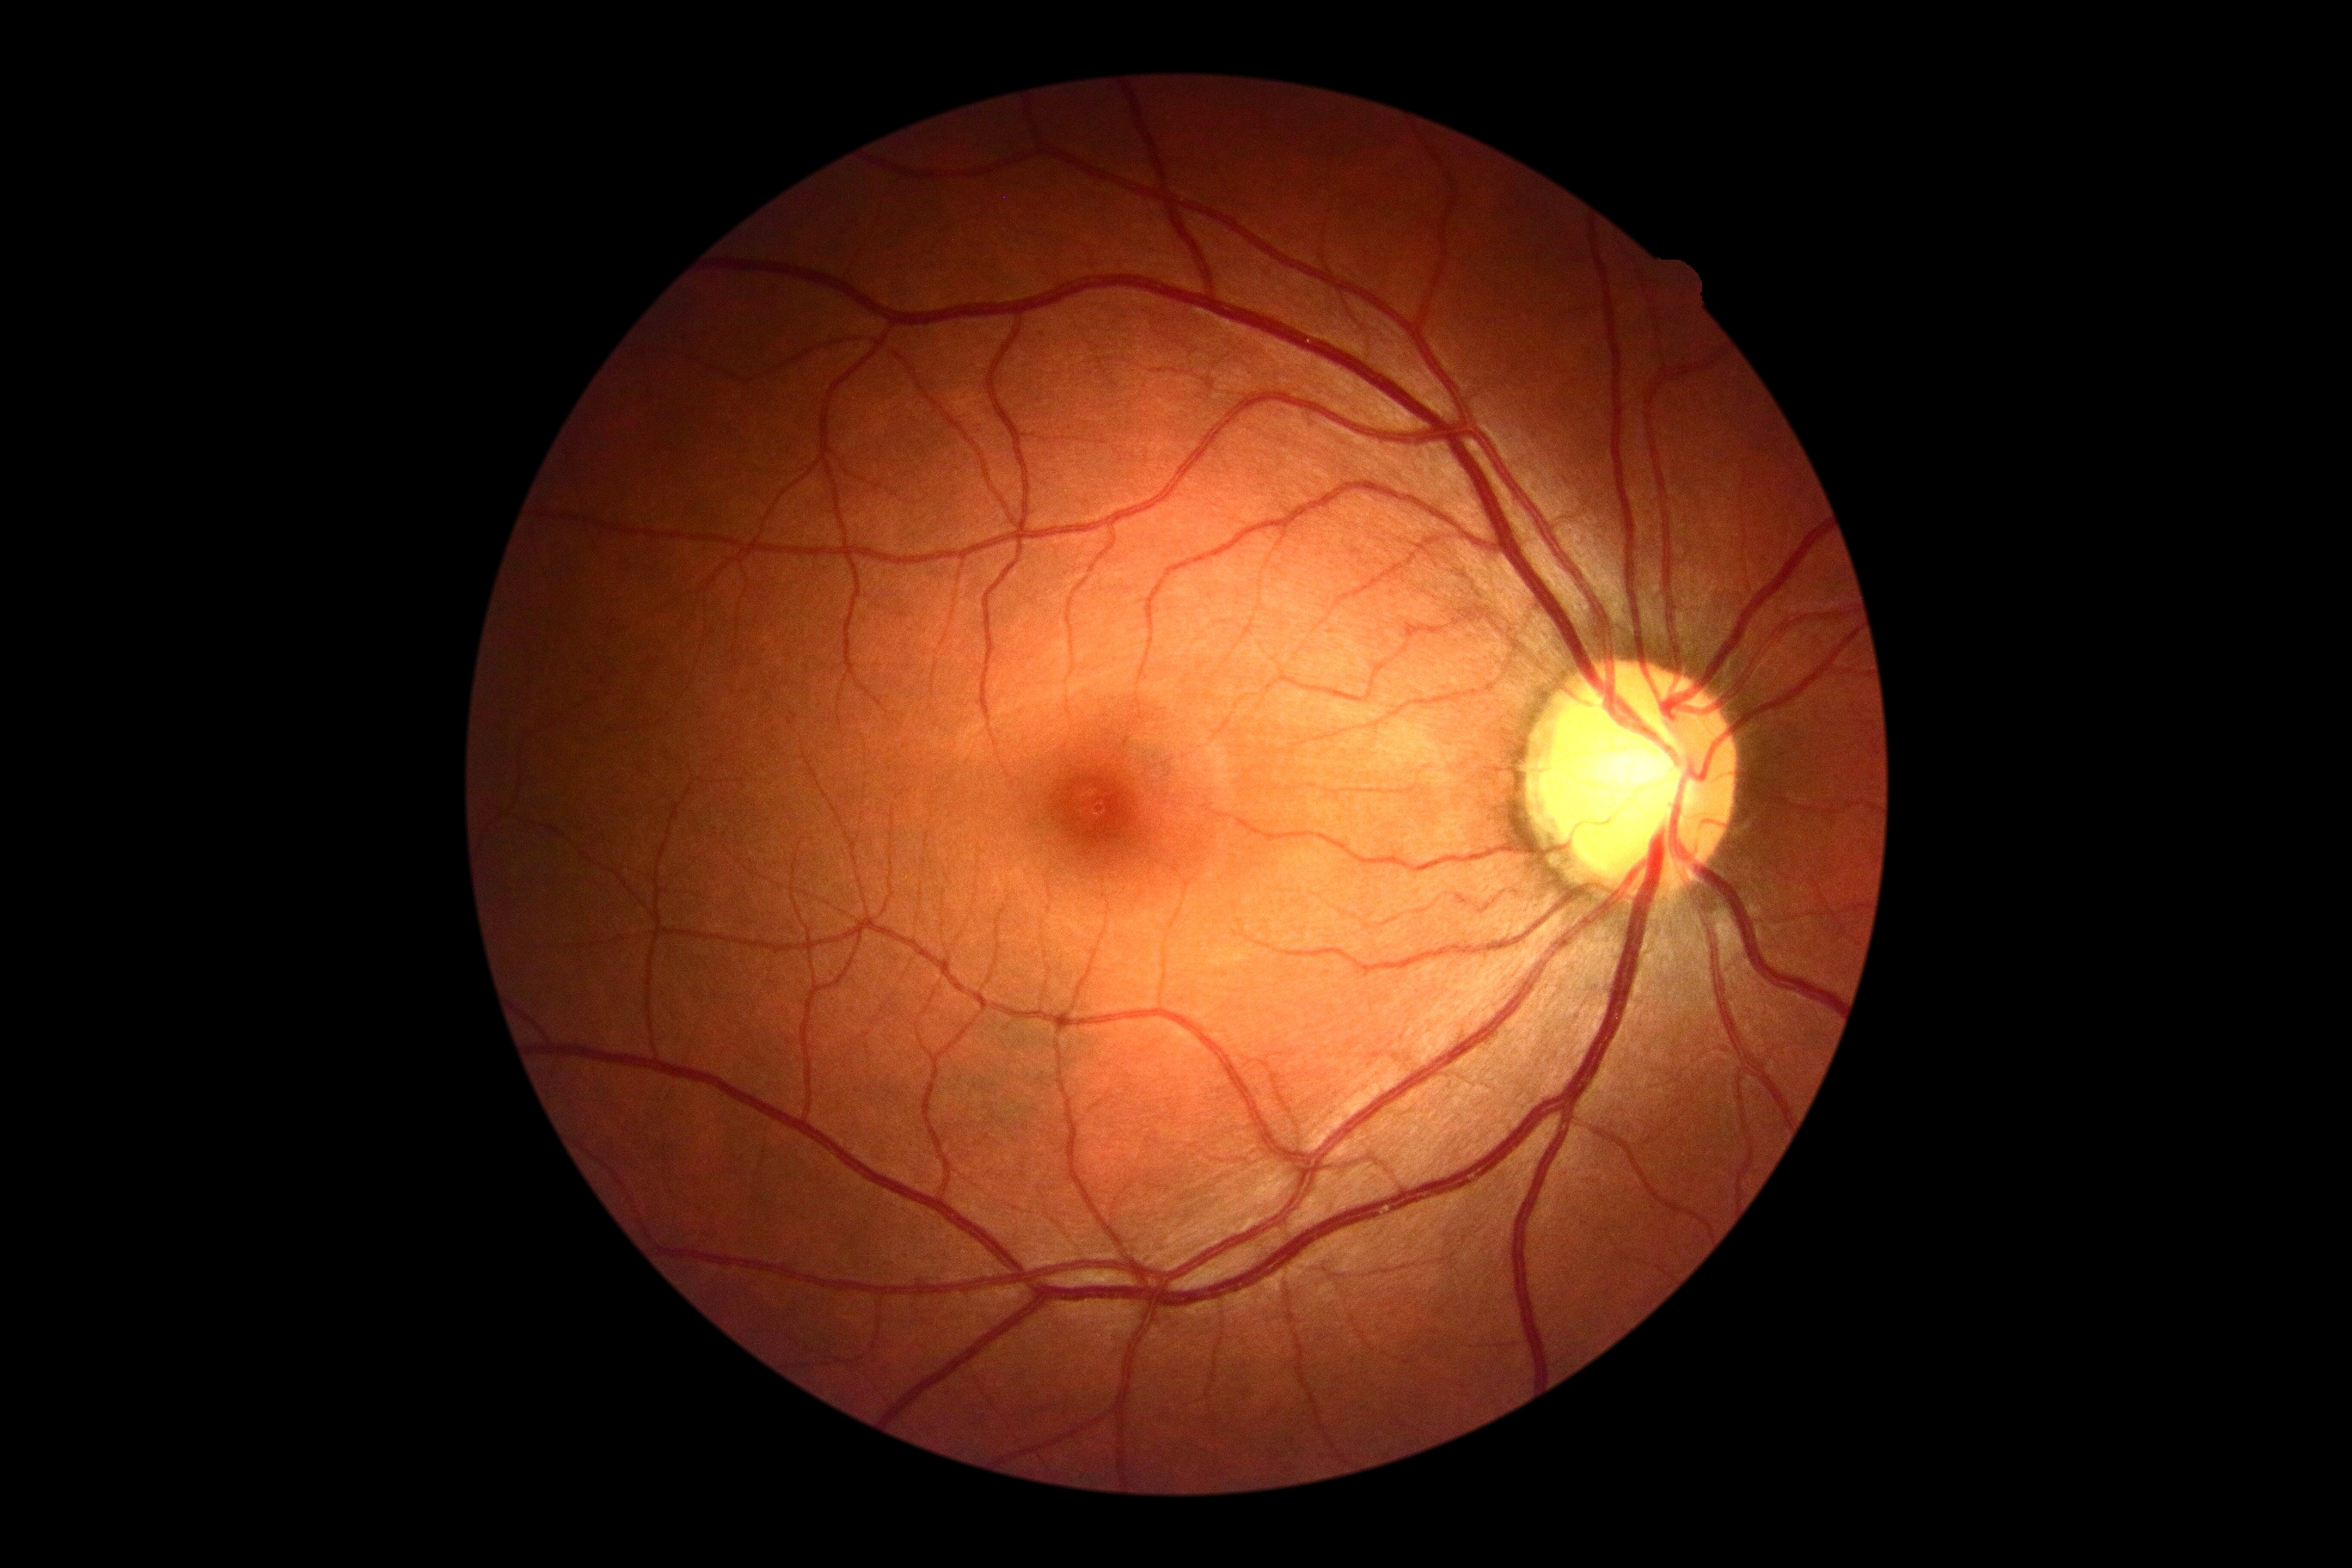

  dr_grade: no apparent diabetic retinopathy (grade 0)